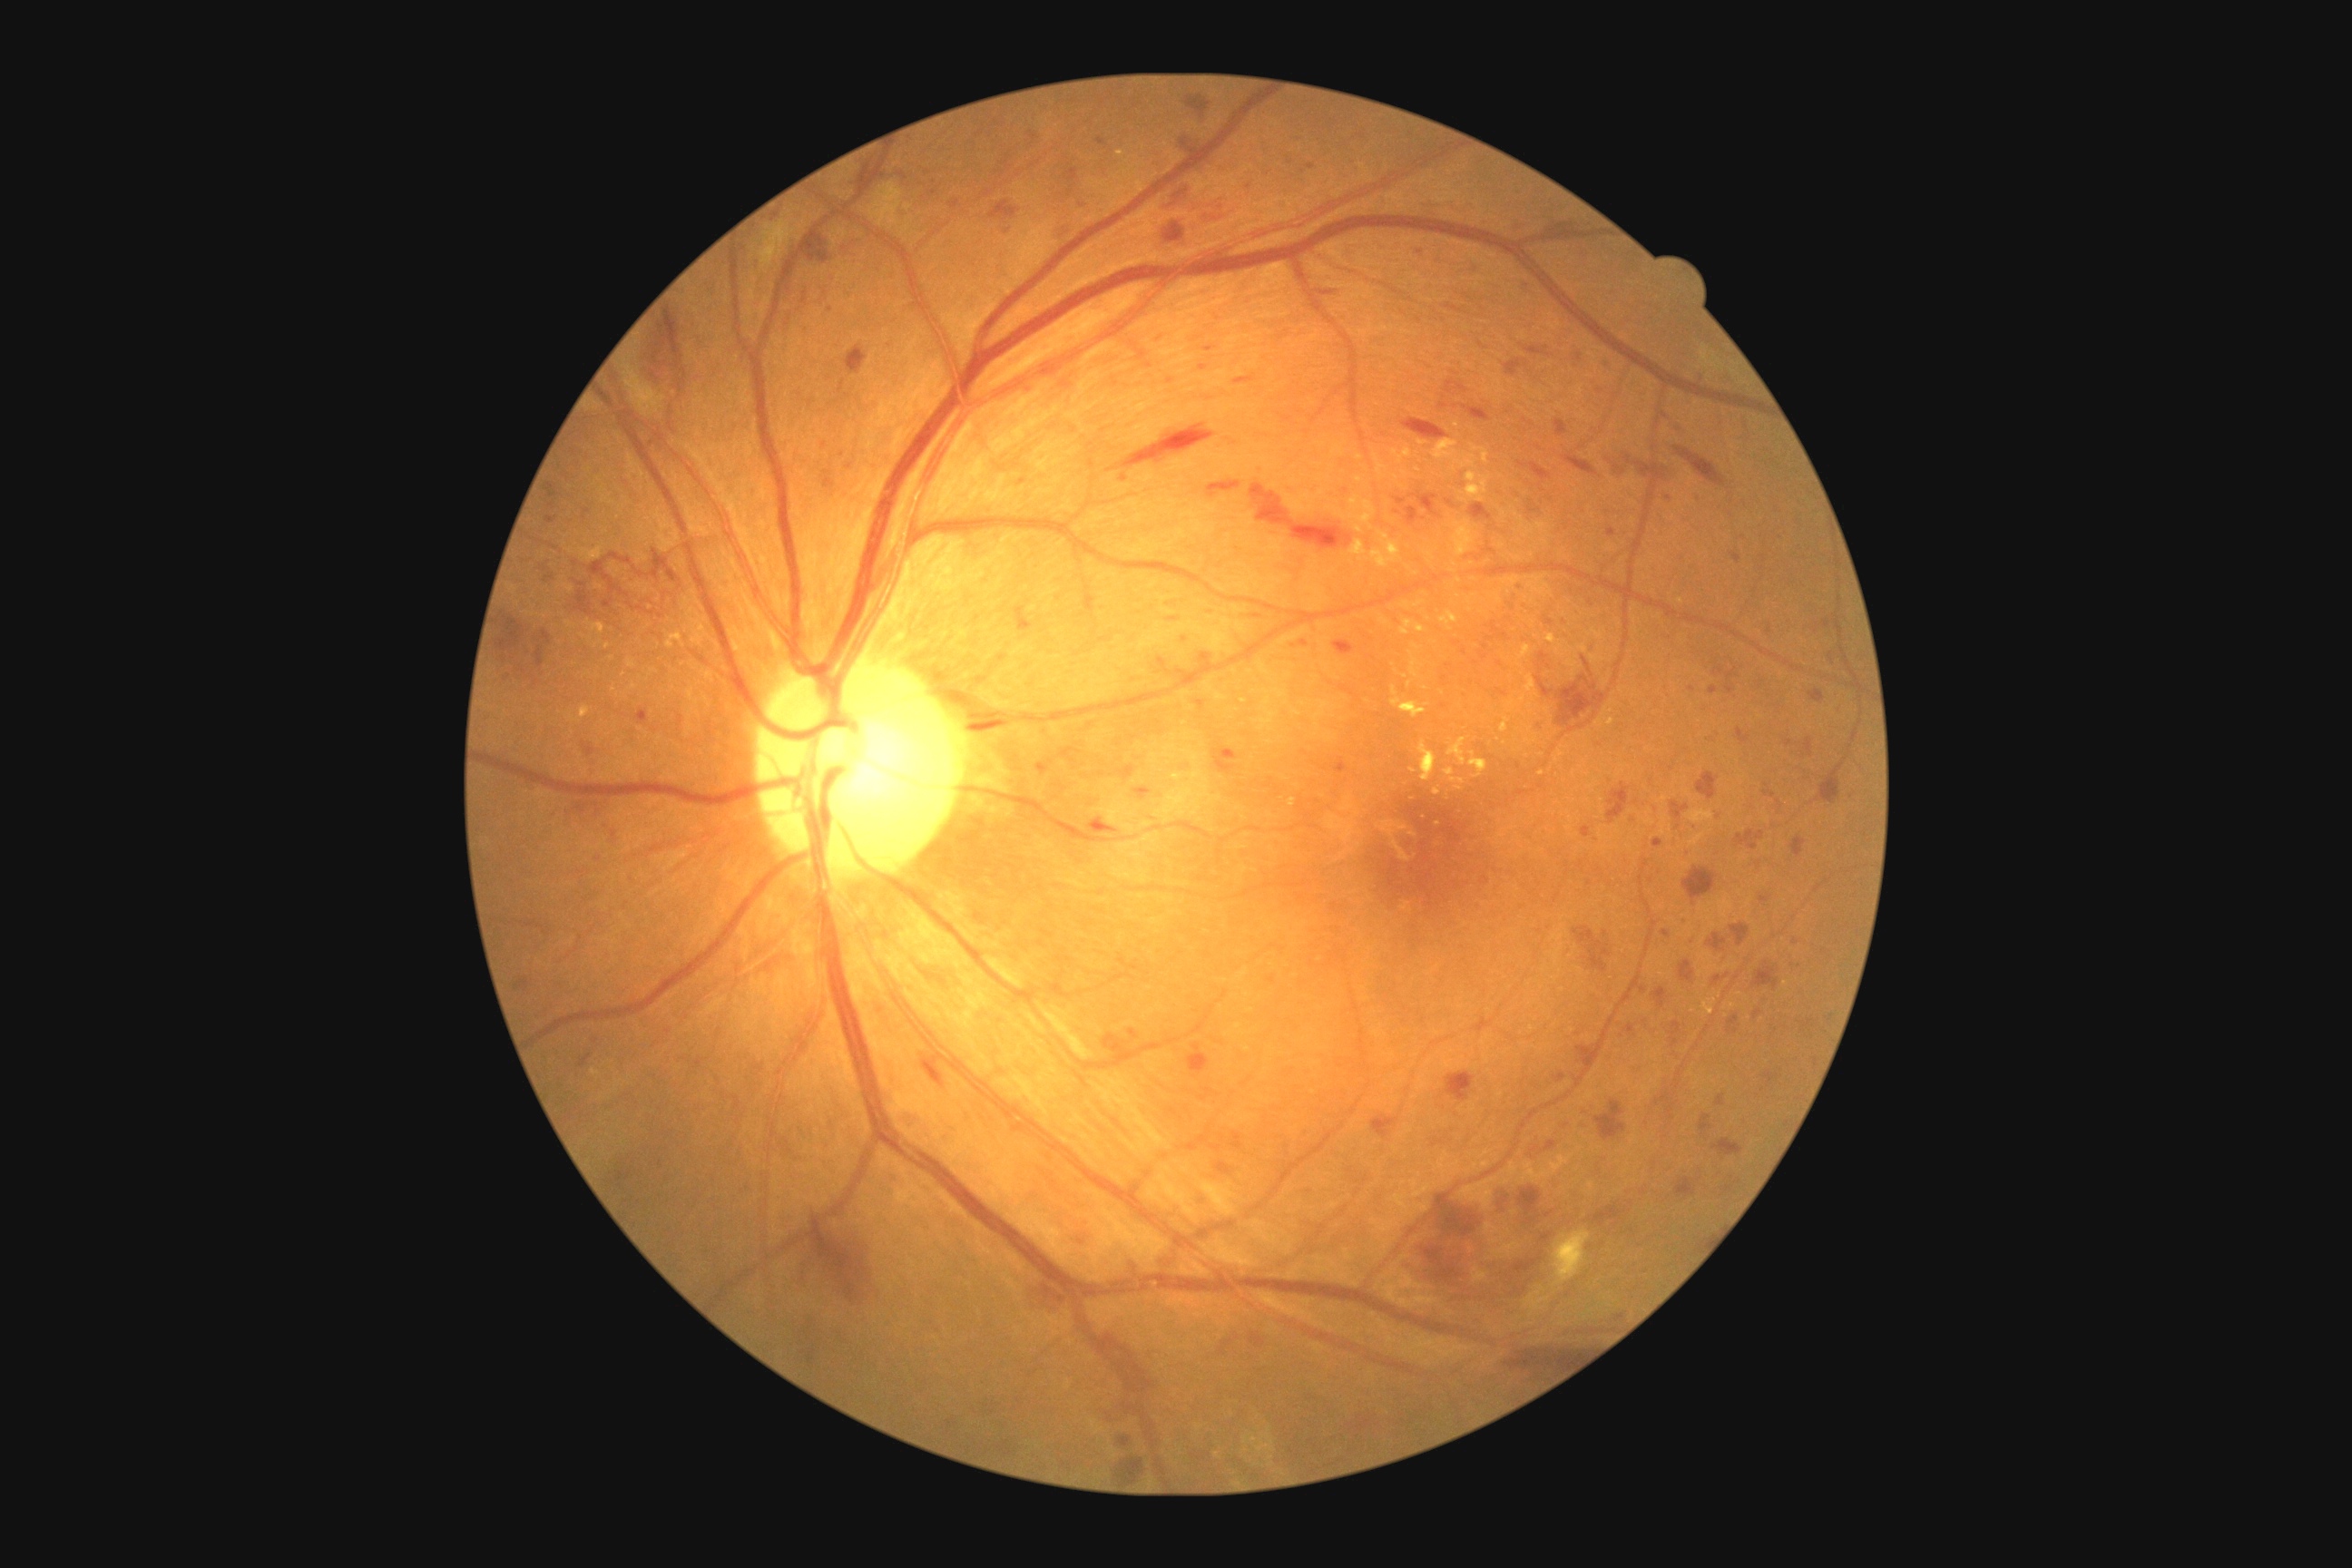 Diabetic retinopathy (DR): grade 3.
Microaneurysms (MAs) include 1654 839 1663 848; 1220 749 1231 760; 948 201 959 210; 1736 554 1743 562; 1121 475 1128 484; 1732 834 1743 843; 1338 765 1346 770.
Small MAs near [1185, 640]; [1022, 482]; [825, 445]; [1591, 603]; [1290, 163]; [1840, 710]; [1718, 817]; [842, 455]; [850, 467].
Hard exudates (EXs) include 582 705 585 716; 627 660 636 669; 1440 442 1458 449; 596 623 605 636; 667 632 685 651; 1456 549 1465 556; 1446 609 1460 622; 1703 999 1718 1015; 1400 620 1427 636; 1465 471 1491 502; 1380 538 1393 544.
Small EXs near [1396, 478]; [1457, 426]; [1429, 619]; [1360, 457]; [1785, 983]; [1471, 610]; [1404, 473]; [1217, 1455].
Hemorrhages (HEs) include 1736 830 1765 850; 1602 358 1611 369; 1184 95 1211 119; 1357 1418 1371 1431; 1810 689 1825 705; 1536 676 1554 698; 1464 406 1491 422; 1573 926 1612 974; 496 618 525 651; 534 645 545 669; 1505 217 1522 230; 1614 1315 1625 1322; 1504 358 1522 377; 1727 1028 1738 1034; 1612 466 1625 476; 1200 654 1211 665; 1578 1046 1594 1064; 1594 1202 1625 1226; 807 1215 861 1302.
Small HEs near [1510, 606].